Nonmydriatic fundus photograph · acquired with a NIDEK AFC-230 · CFP: 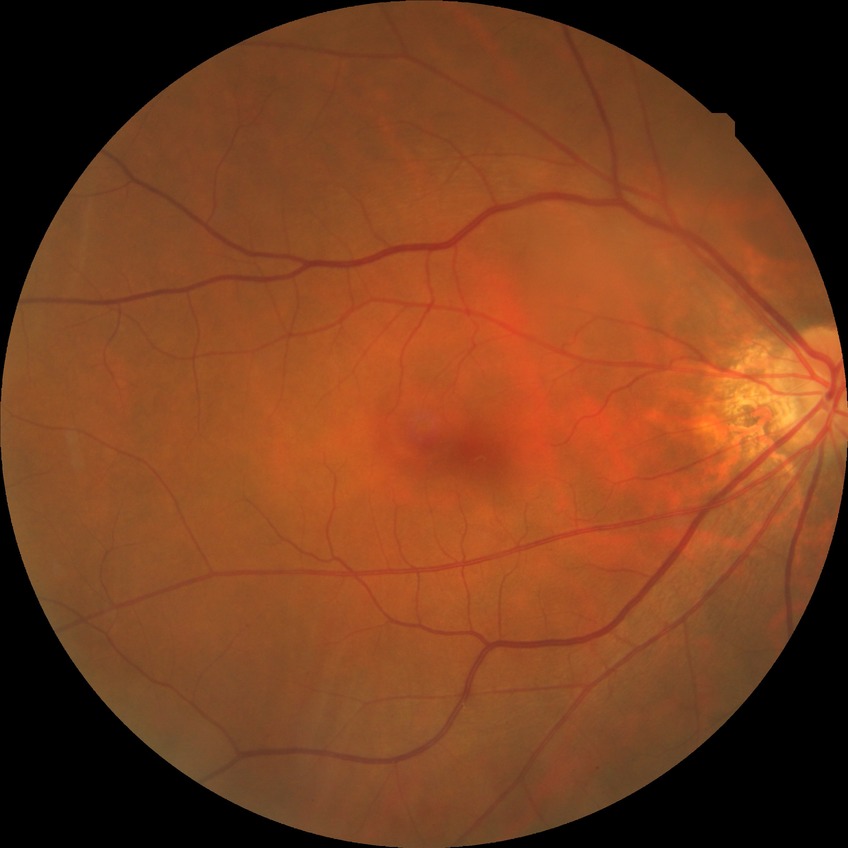
Diabetic retinopathy (DR): no diabetic retinopathy (NDR).